Modified Davis grading.
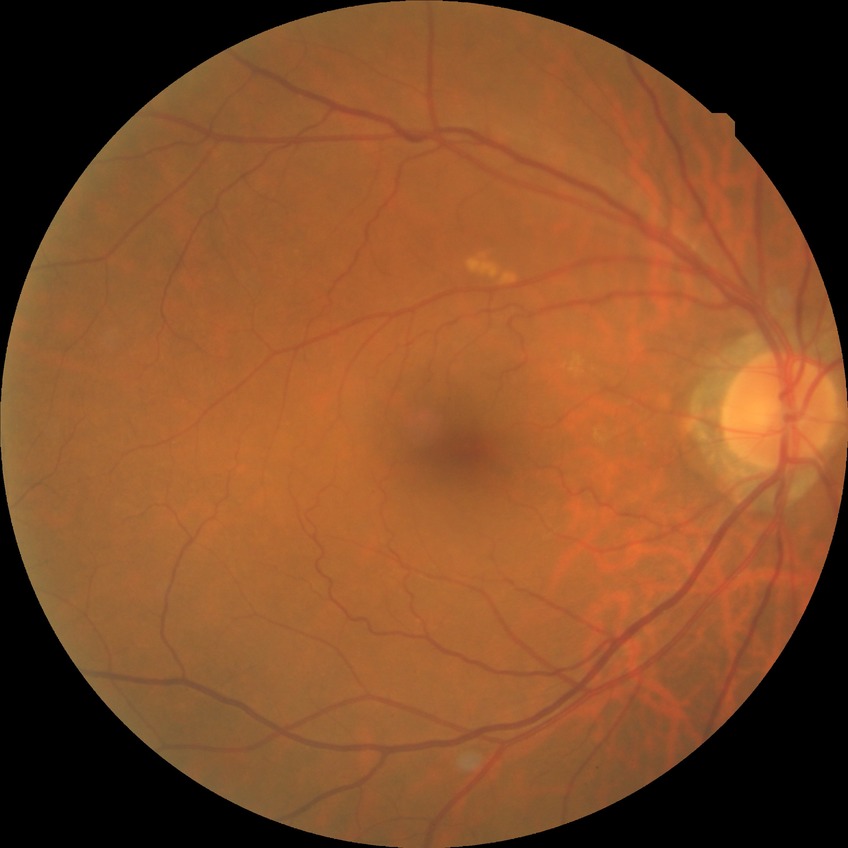 diabetic retinopathy (DR): NDR (no diabetic retinopathy).